Acquired on the Phoenix ICON · infant wide-field retinal image
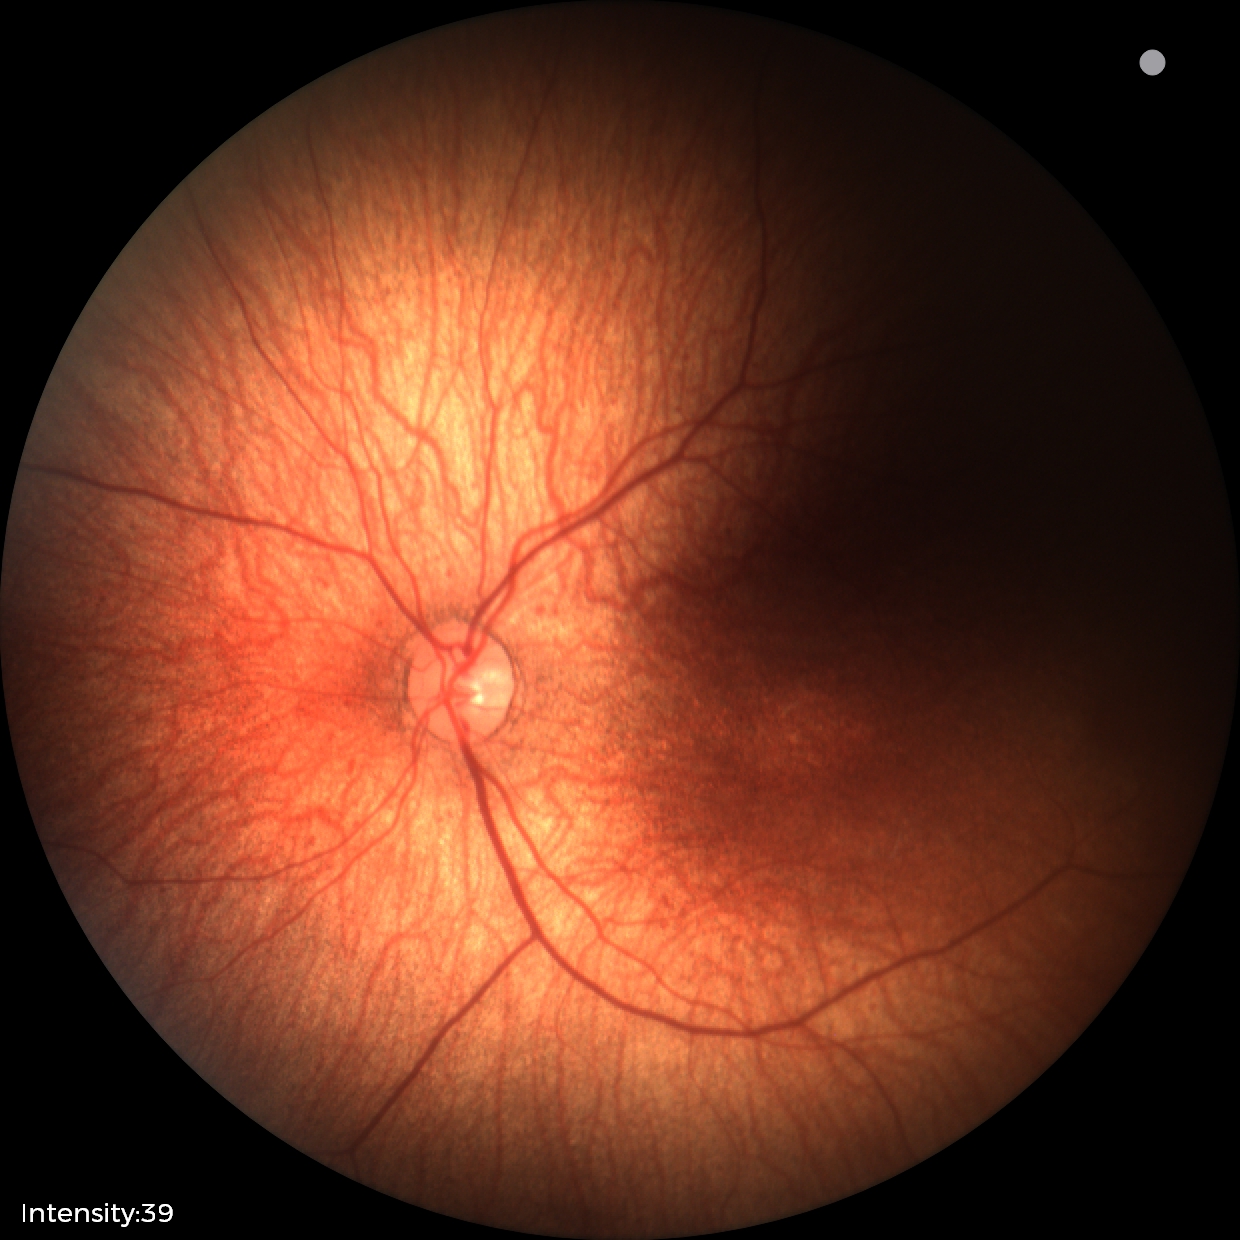
Physiological retinal appearance for postconceptual age.